2352 x 1568 pixels: 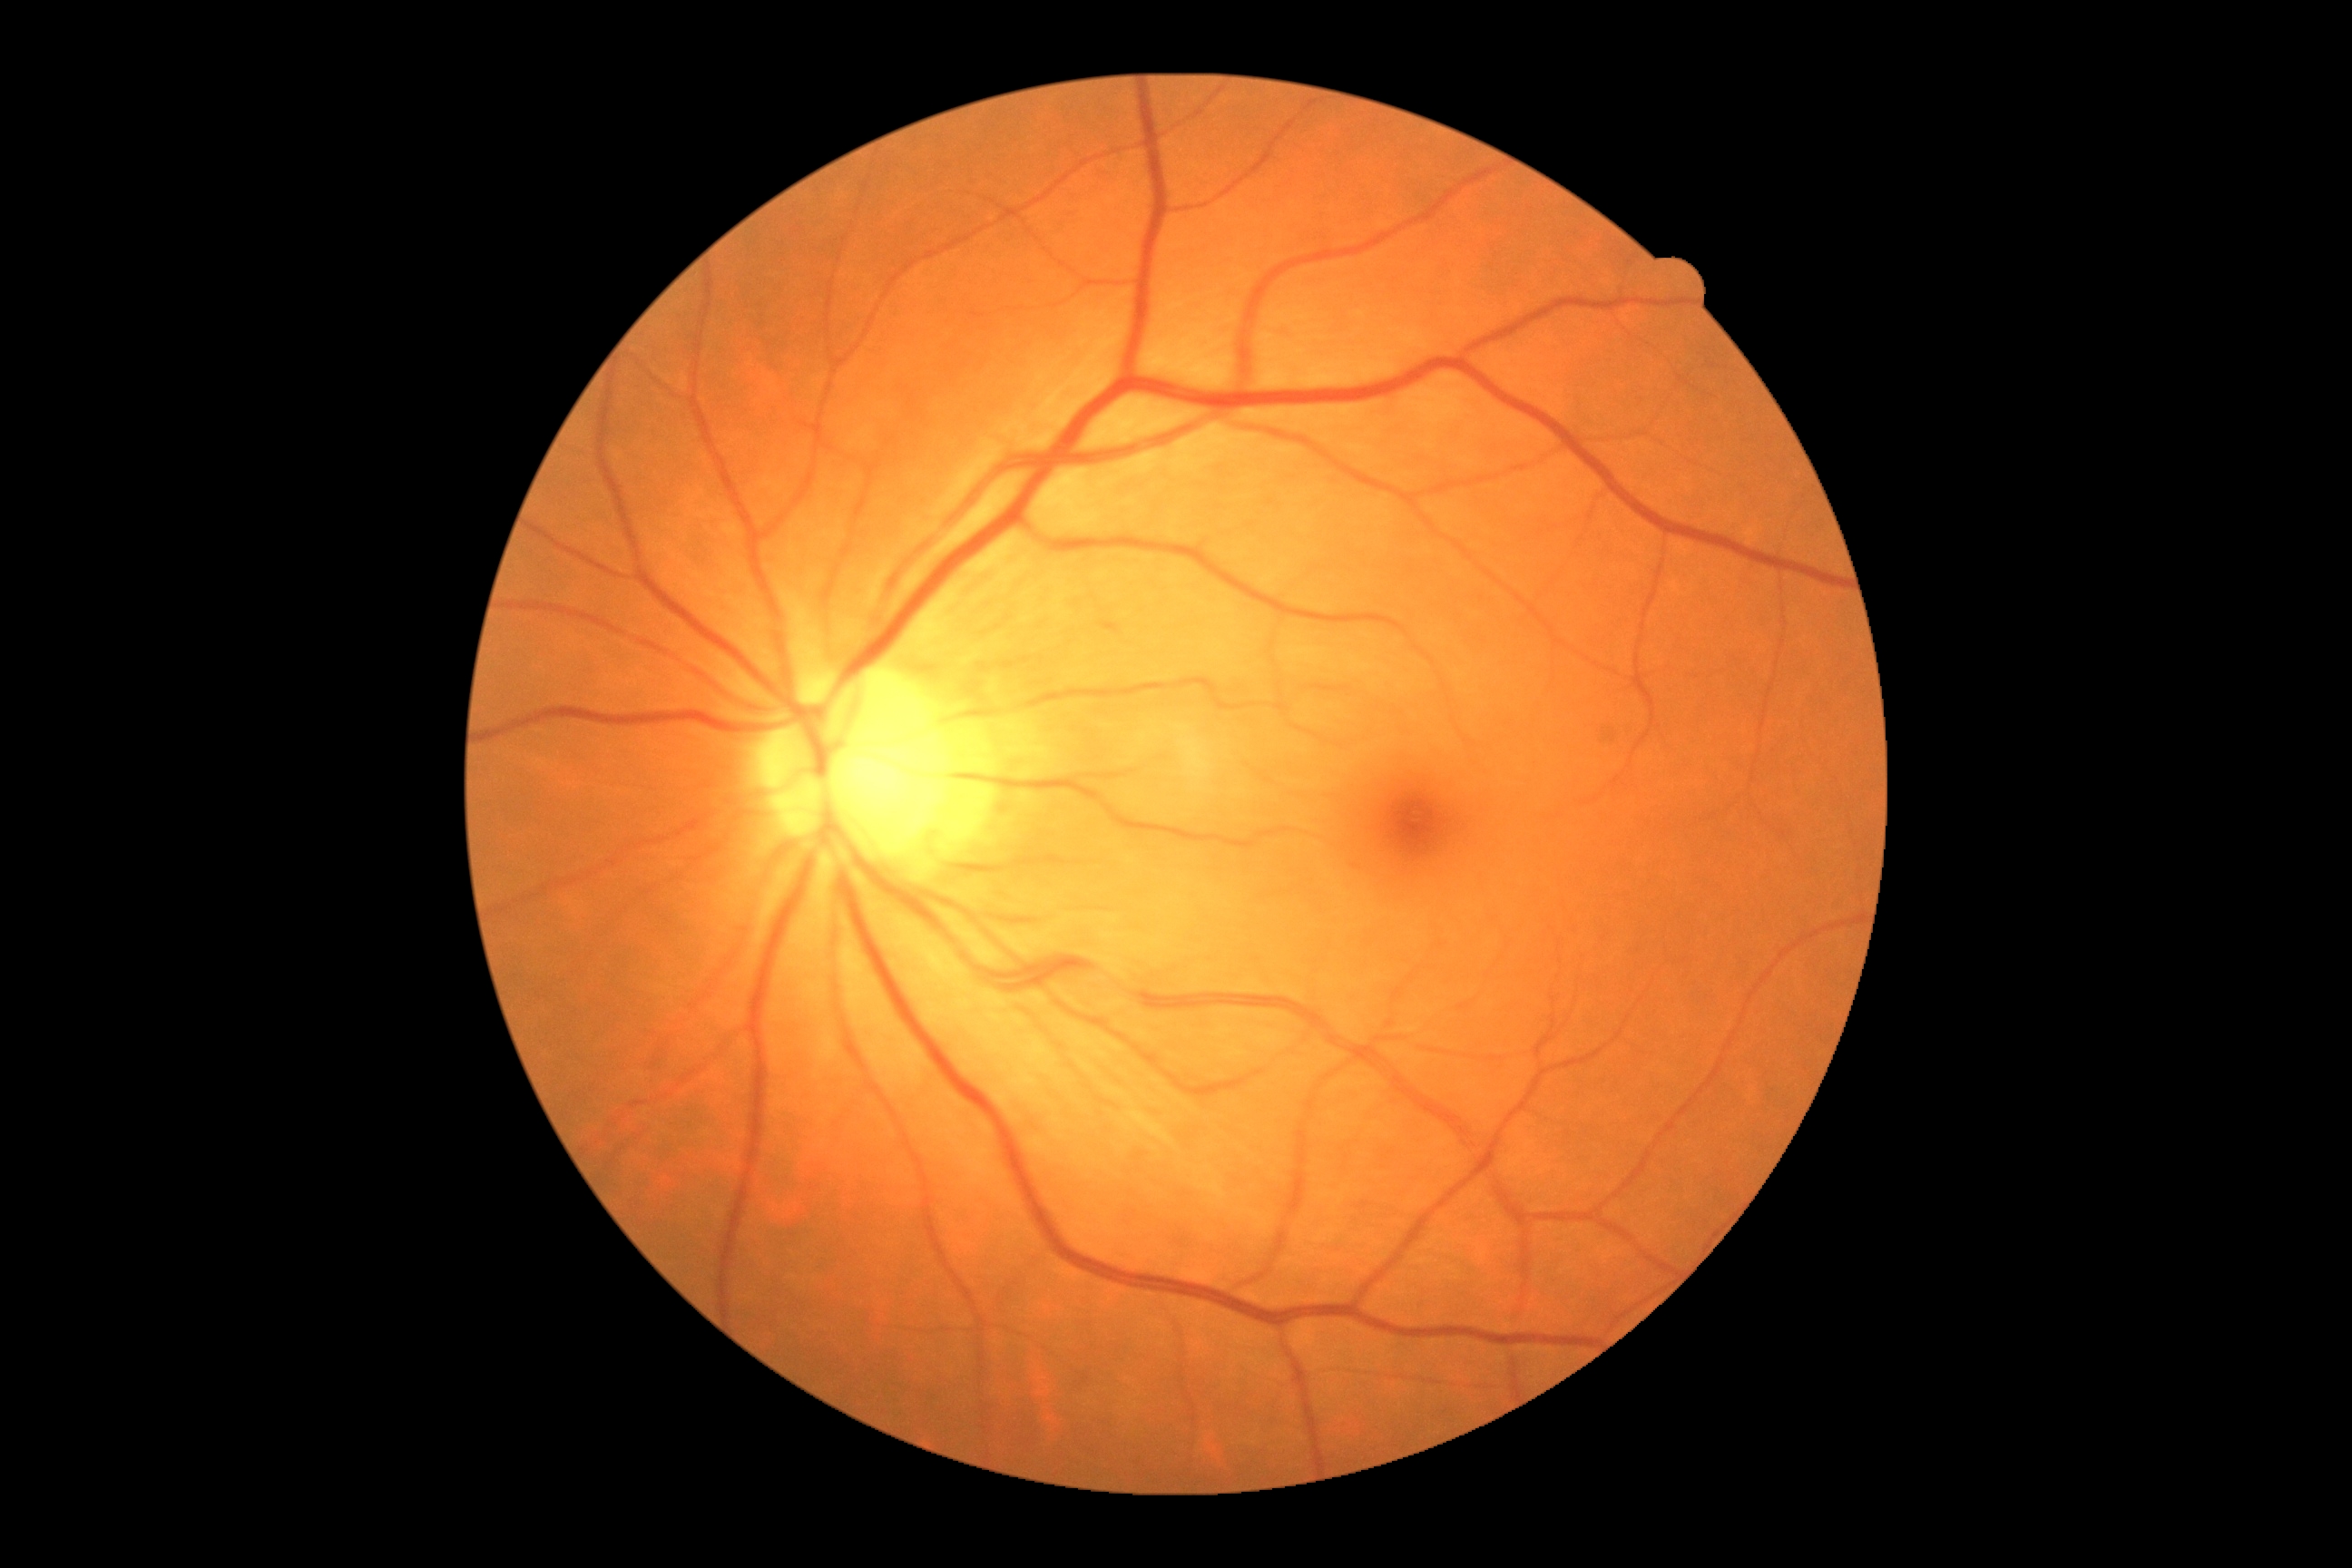 diabetic retinopathy (DR) = grade 0 (no apparent retinopathy) — no visible signs of diabetic retinopathy.